45-degree field of view, color fundus photograph
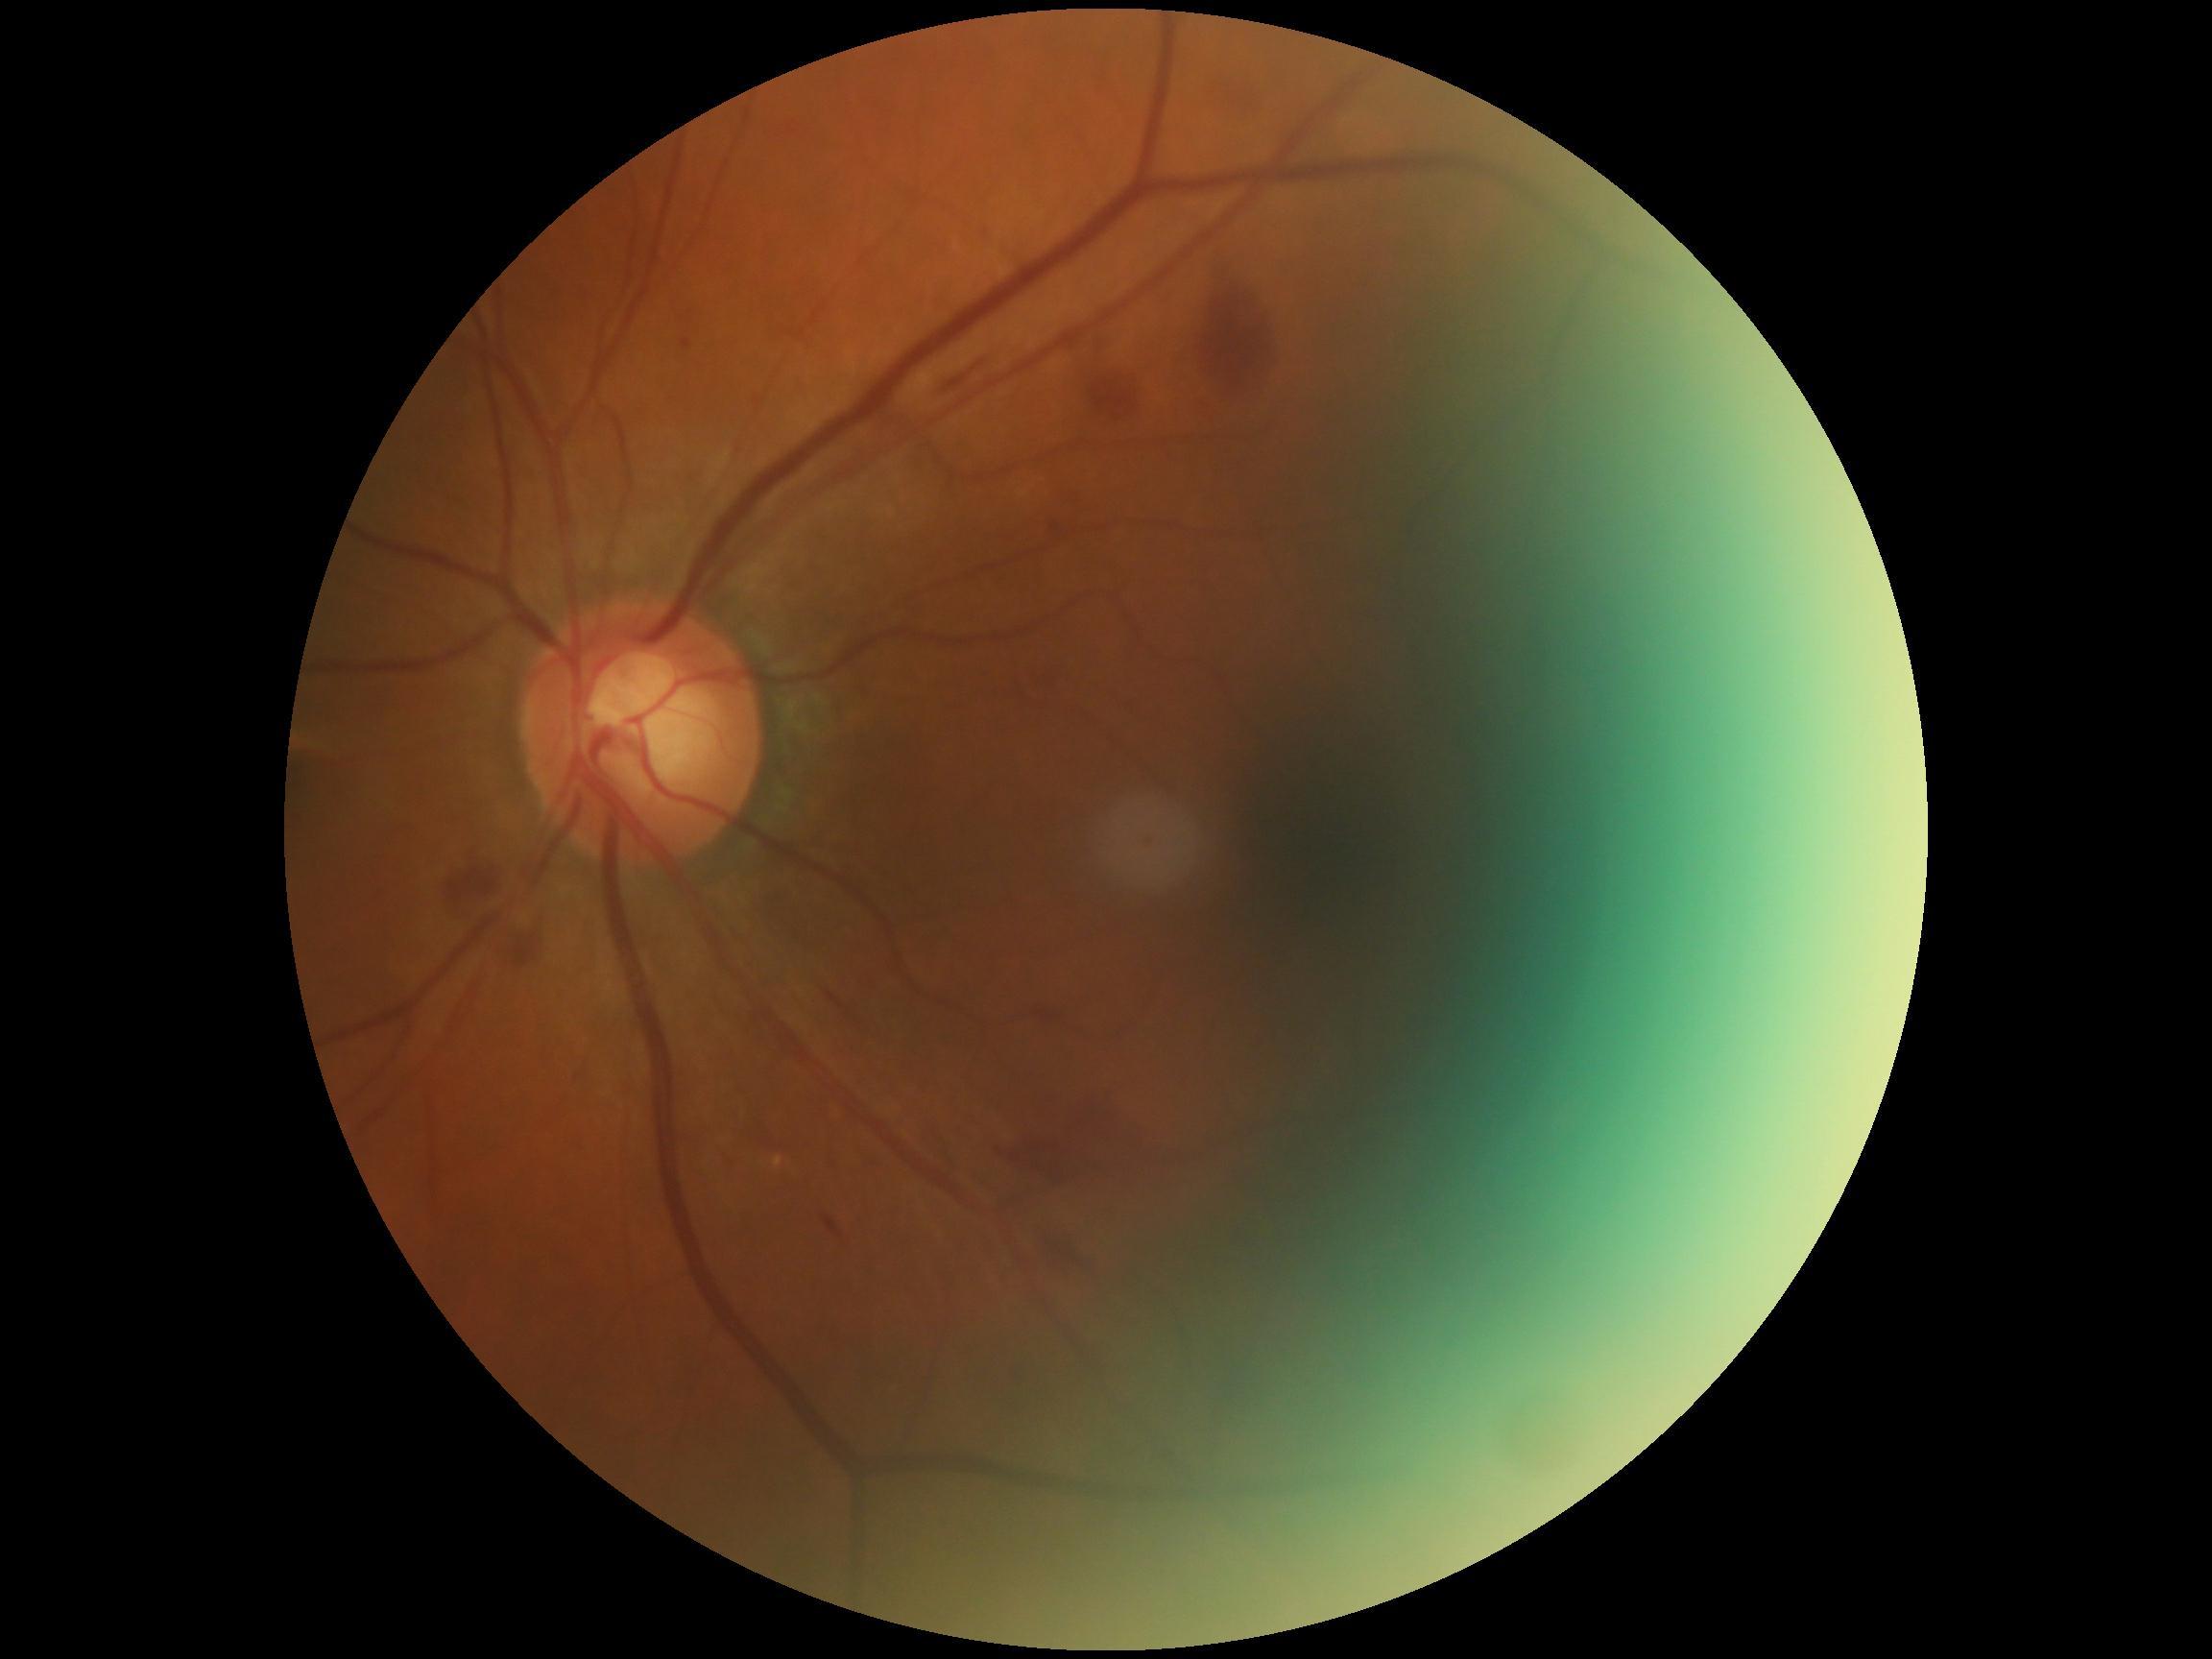

DR stage: grade 2.